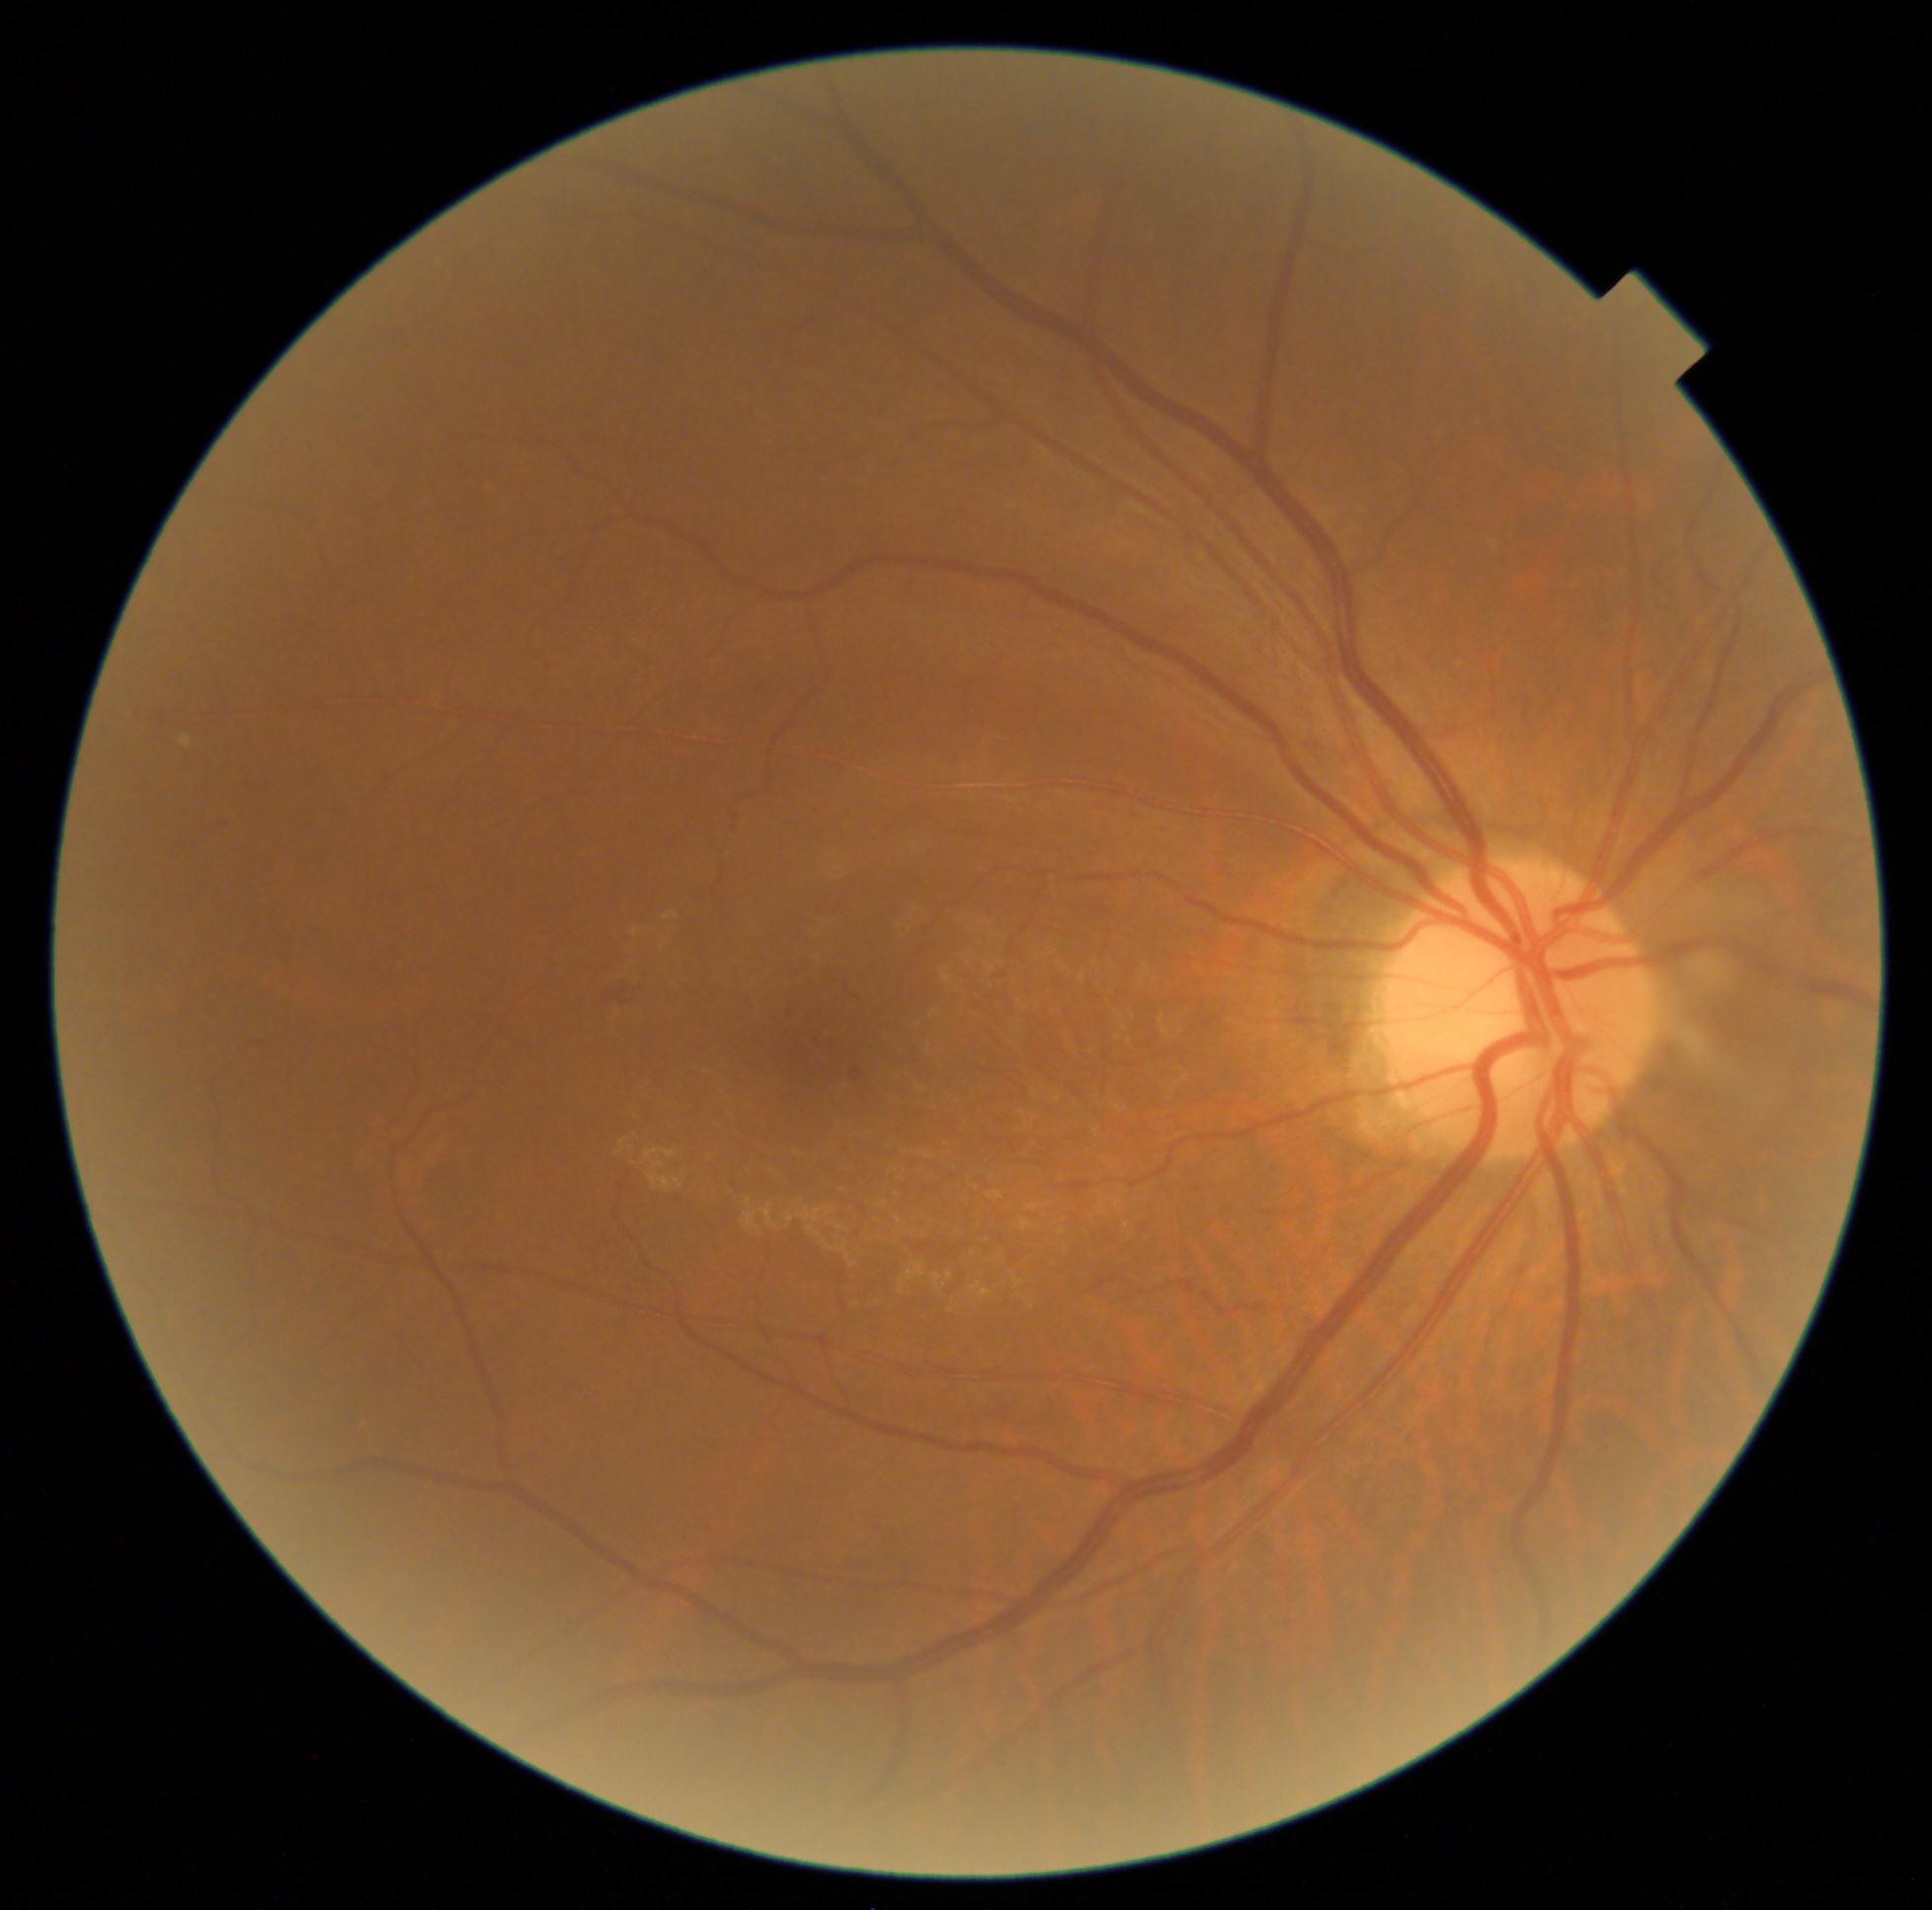
Diabetic retinopathy (DR) is 2
Selected lesions:
soft exudates (SEs): none detected
microaneurysms (MAs) (subset): 786 998 795 1012; 852 1068 863 1080
hemorrhages (HEs): 608 980 639 1007
hard exudates (EXs): none detected